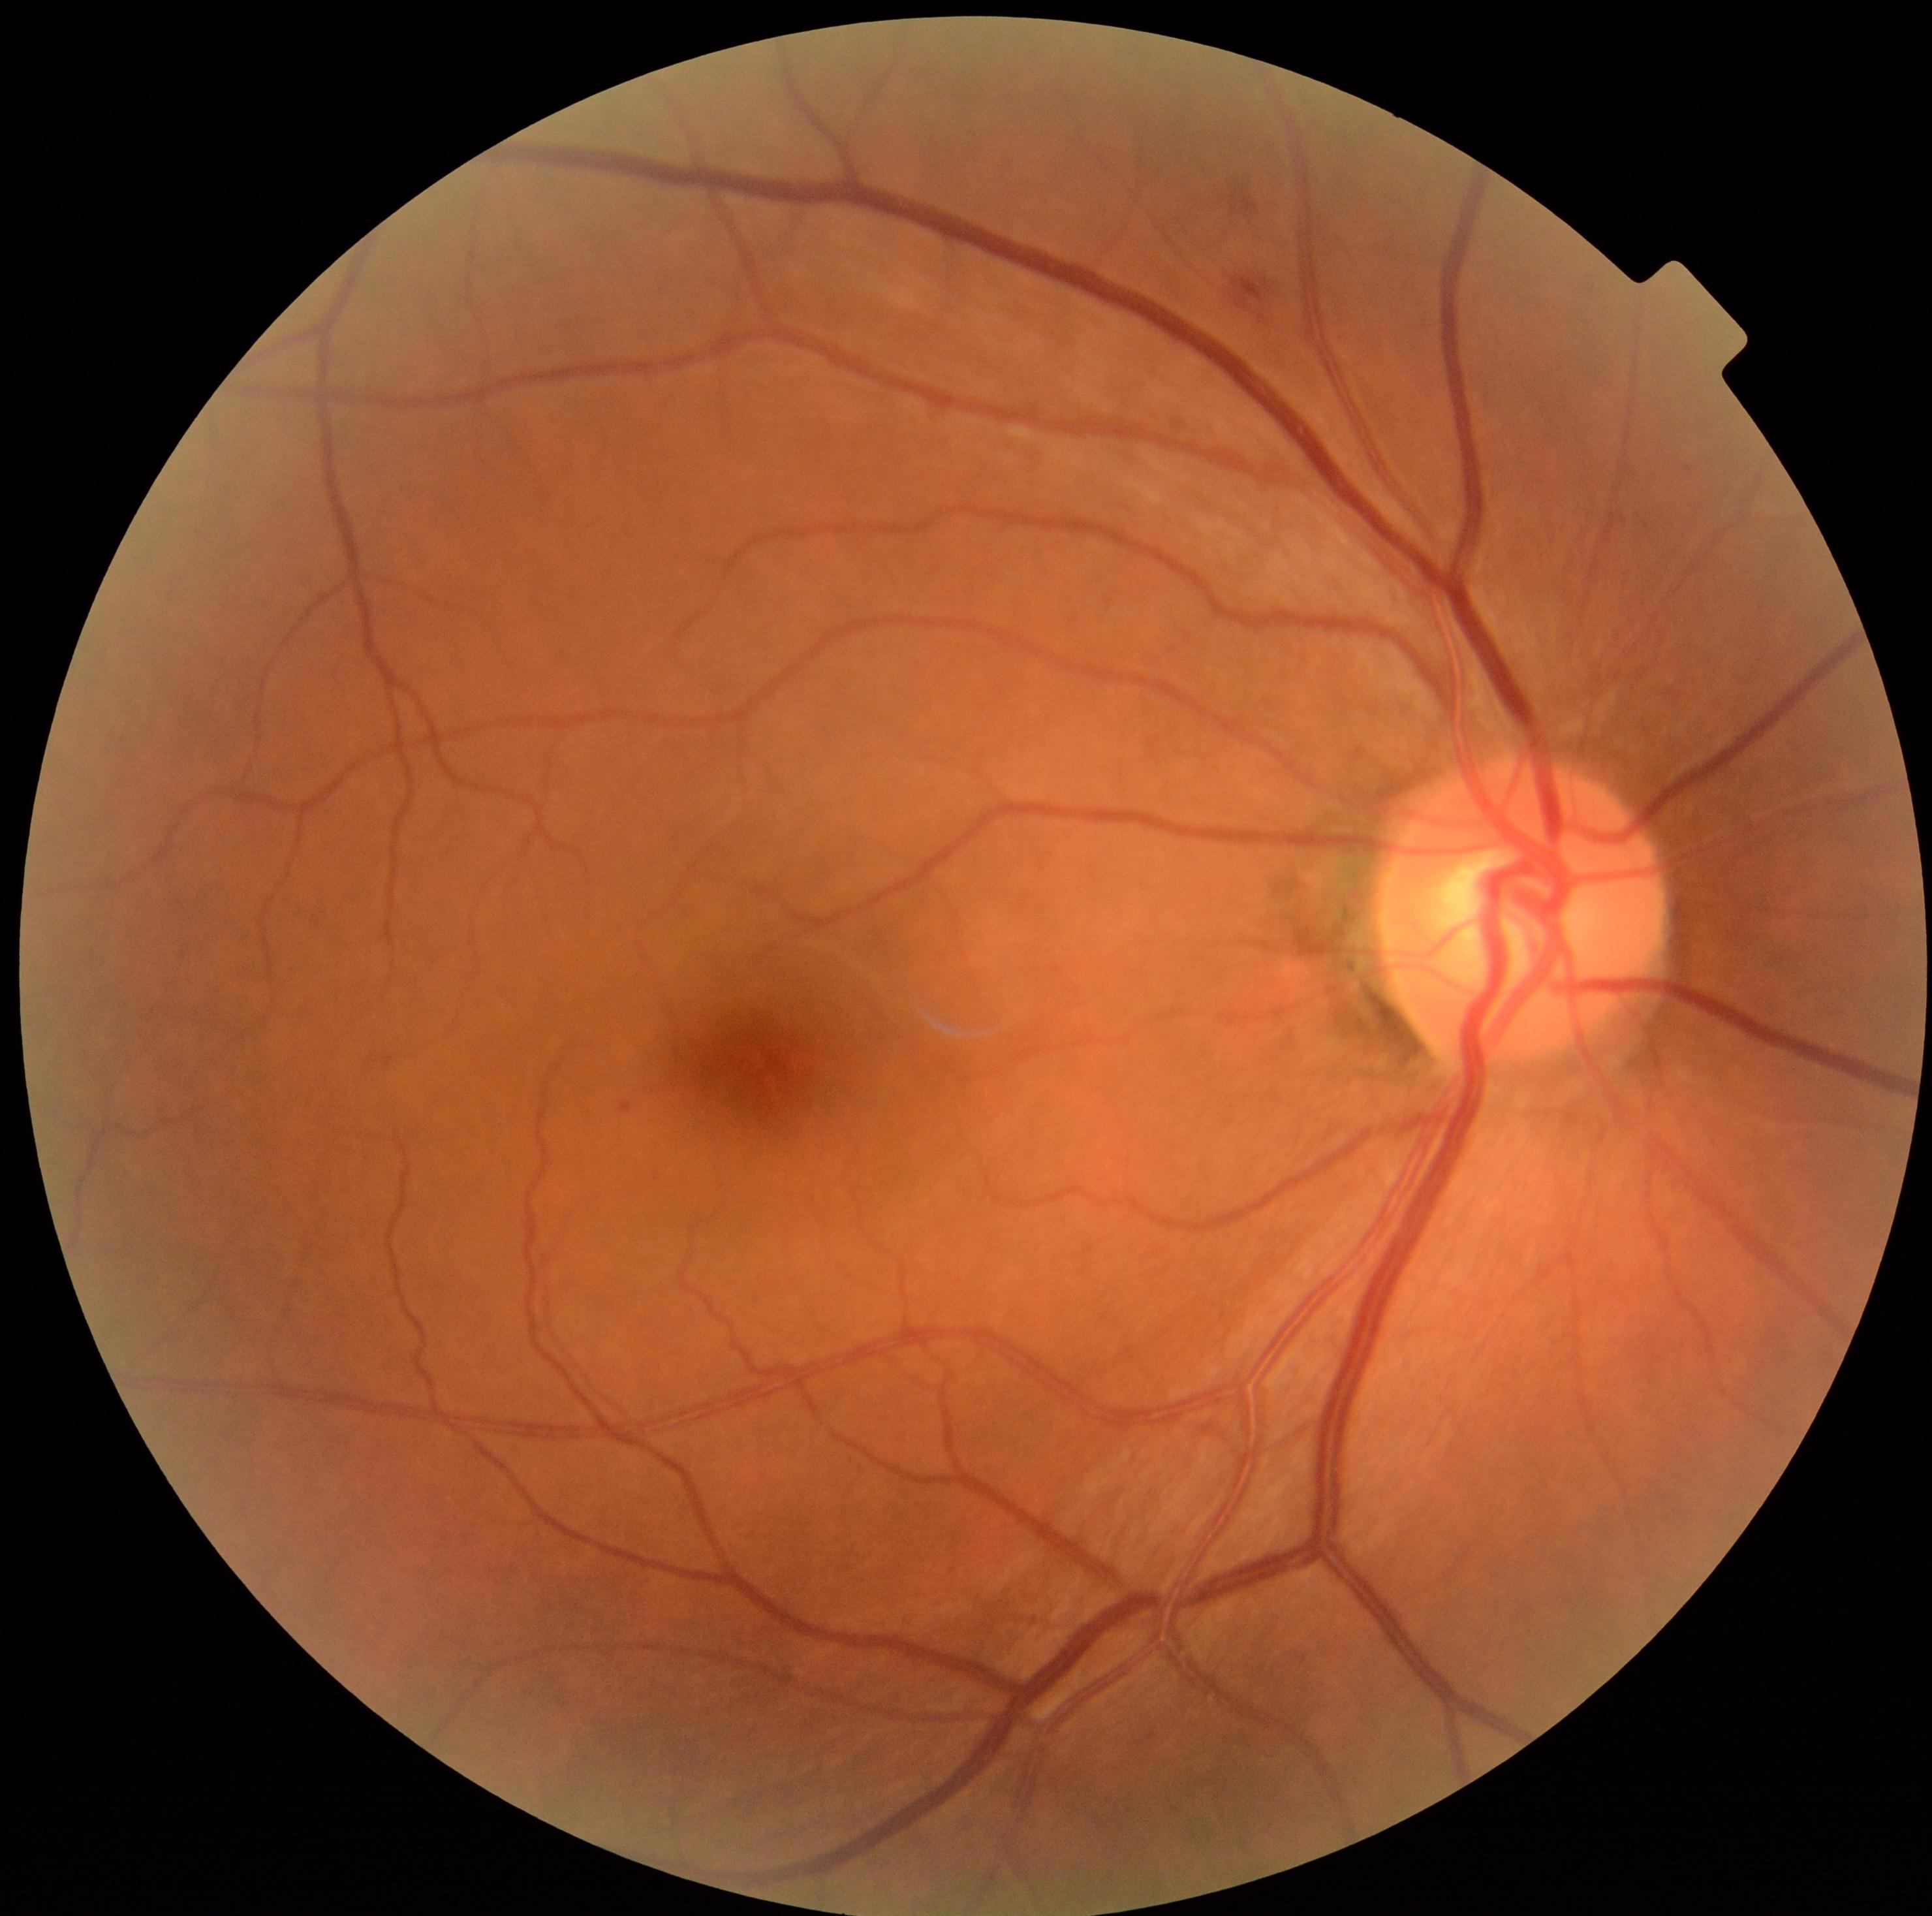 DR grade is moderate NPDR (2). No EXs identified. MAs are present, including at x1=621, y1=1101, x2=631, y2=1112. HEs at x1=1232, y1=200, x2=1258, y2=217; x1=1236, y1=275, x2=1271, y2=302. No SEs identified.